Acquired on the Phoenix ICON · 1240x1240 · pediatric wide-field fundus photograph
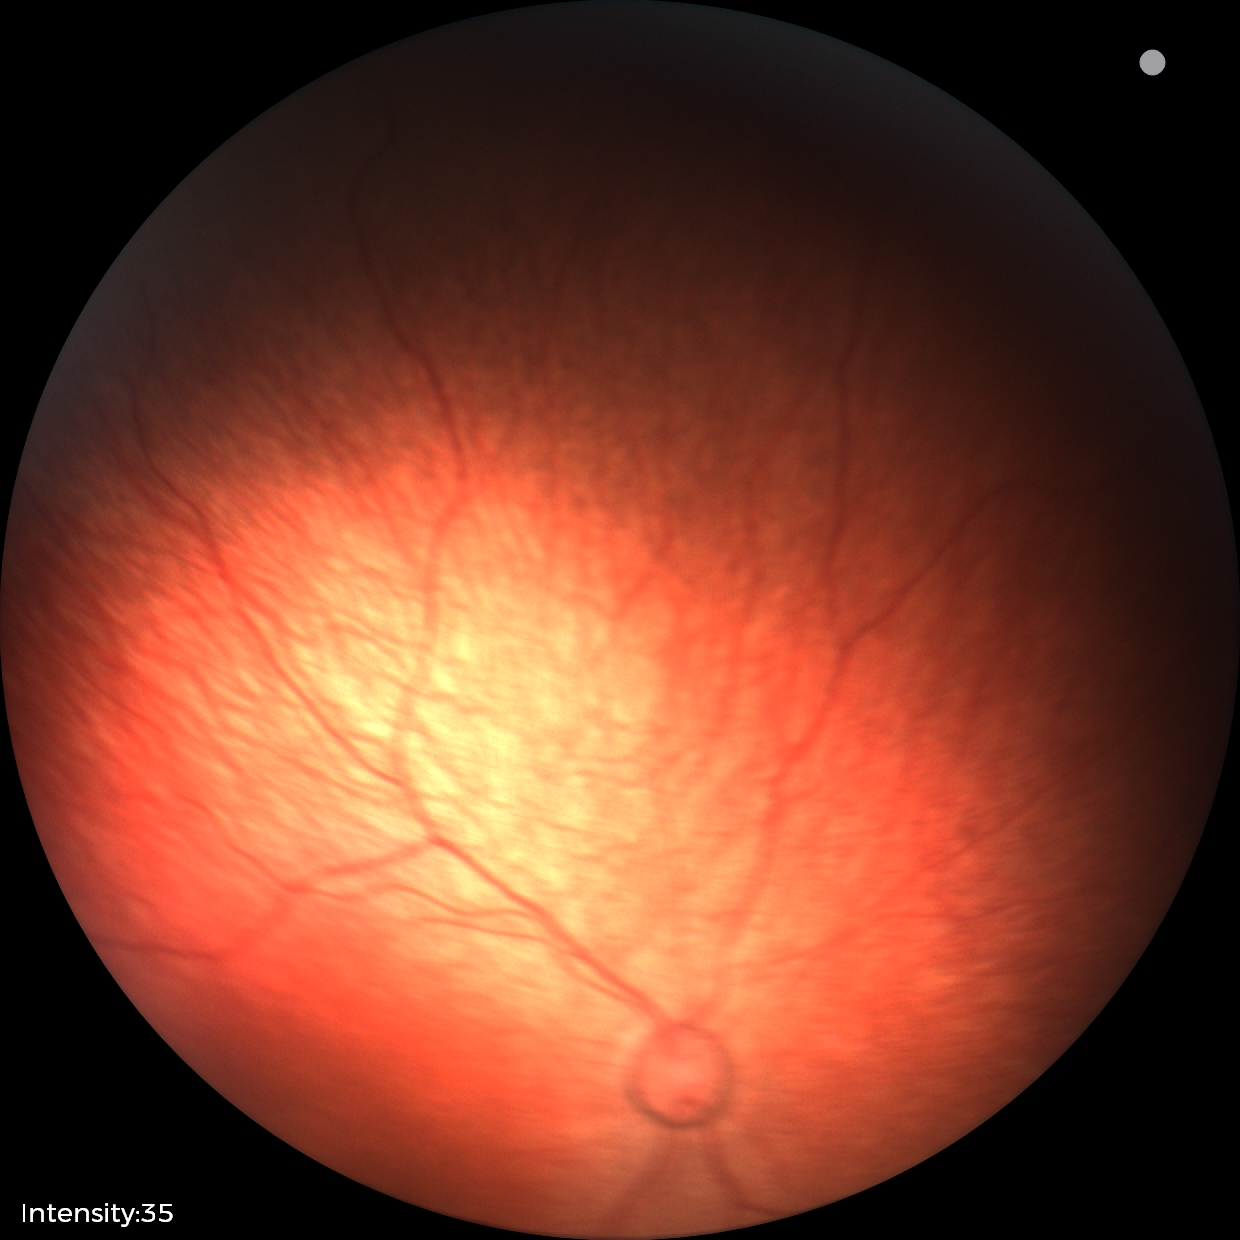

Normal screening examination.